Retinal fundus photograph. Image size 1536x1152. FOV: 45 degrees
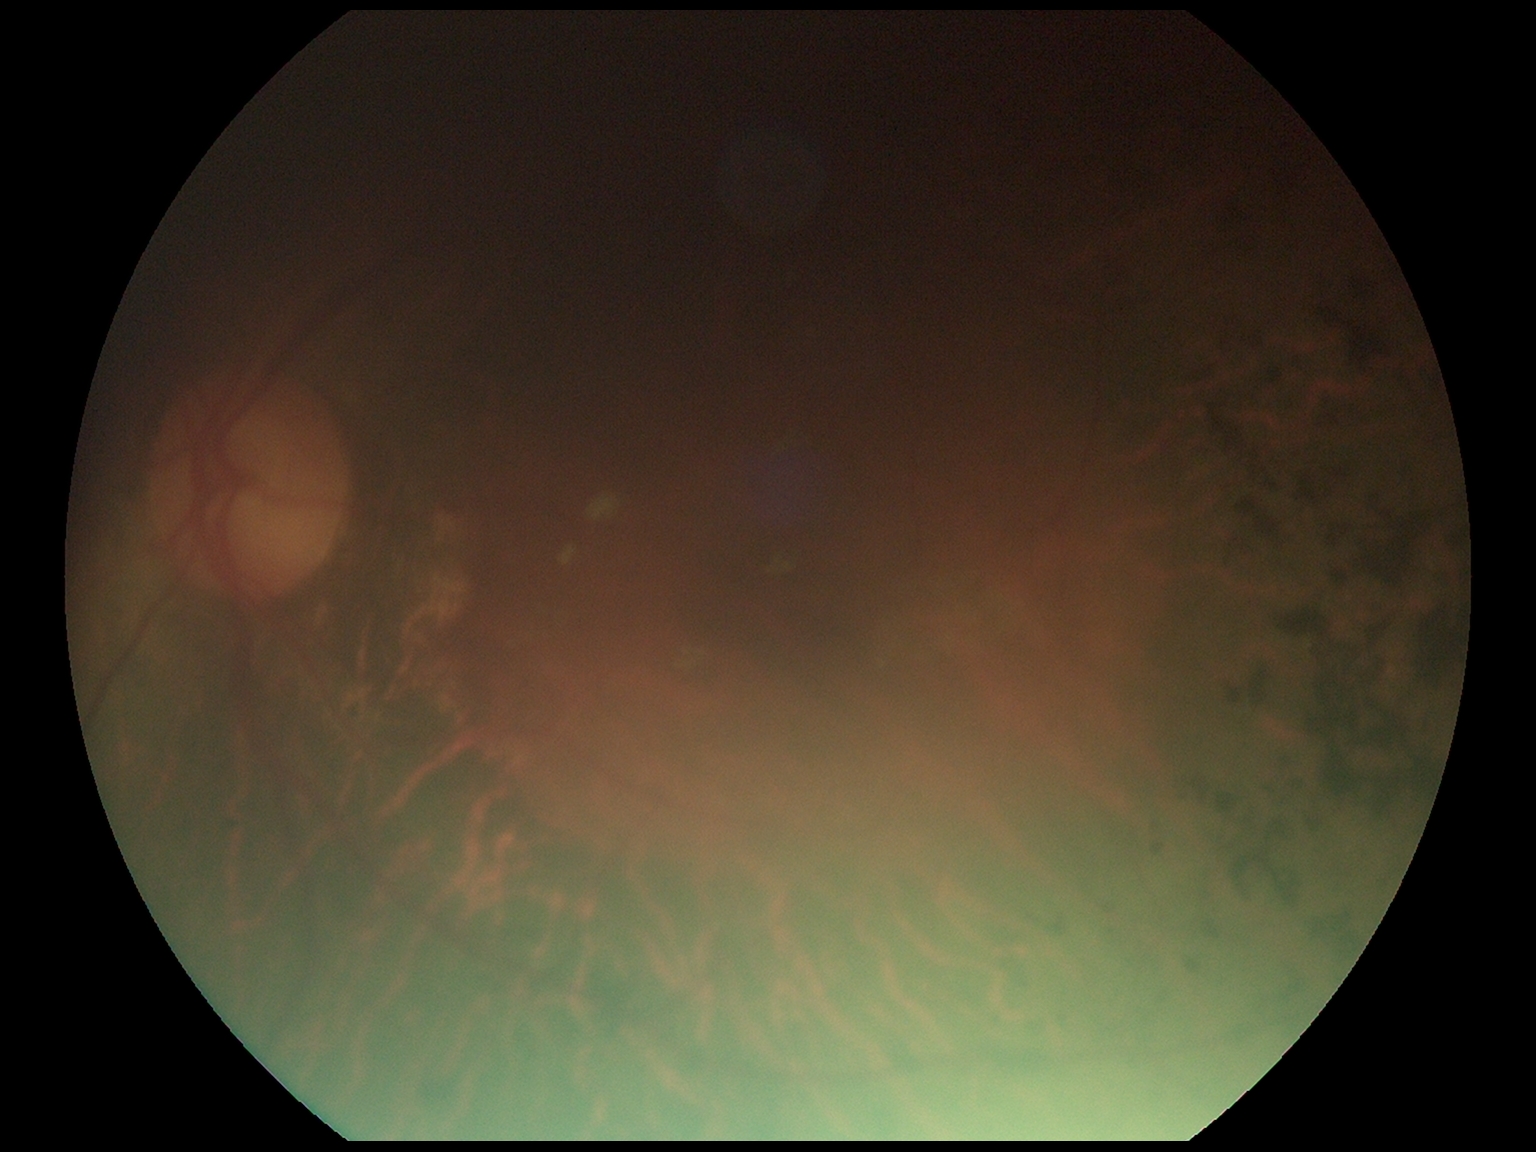 DR severity is moderate NPDR (grade 2).